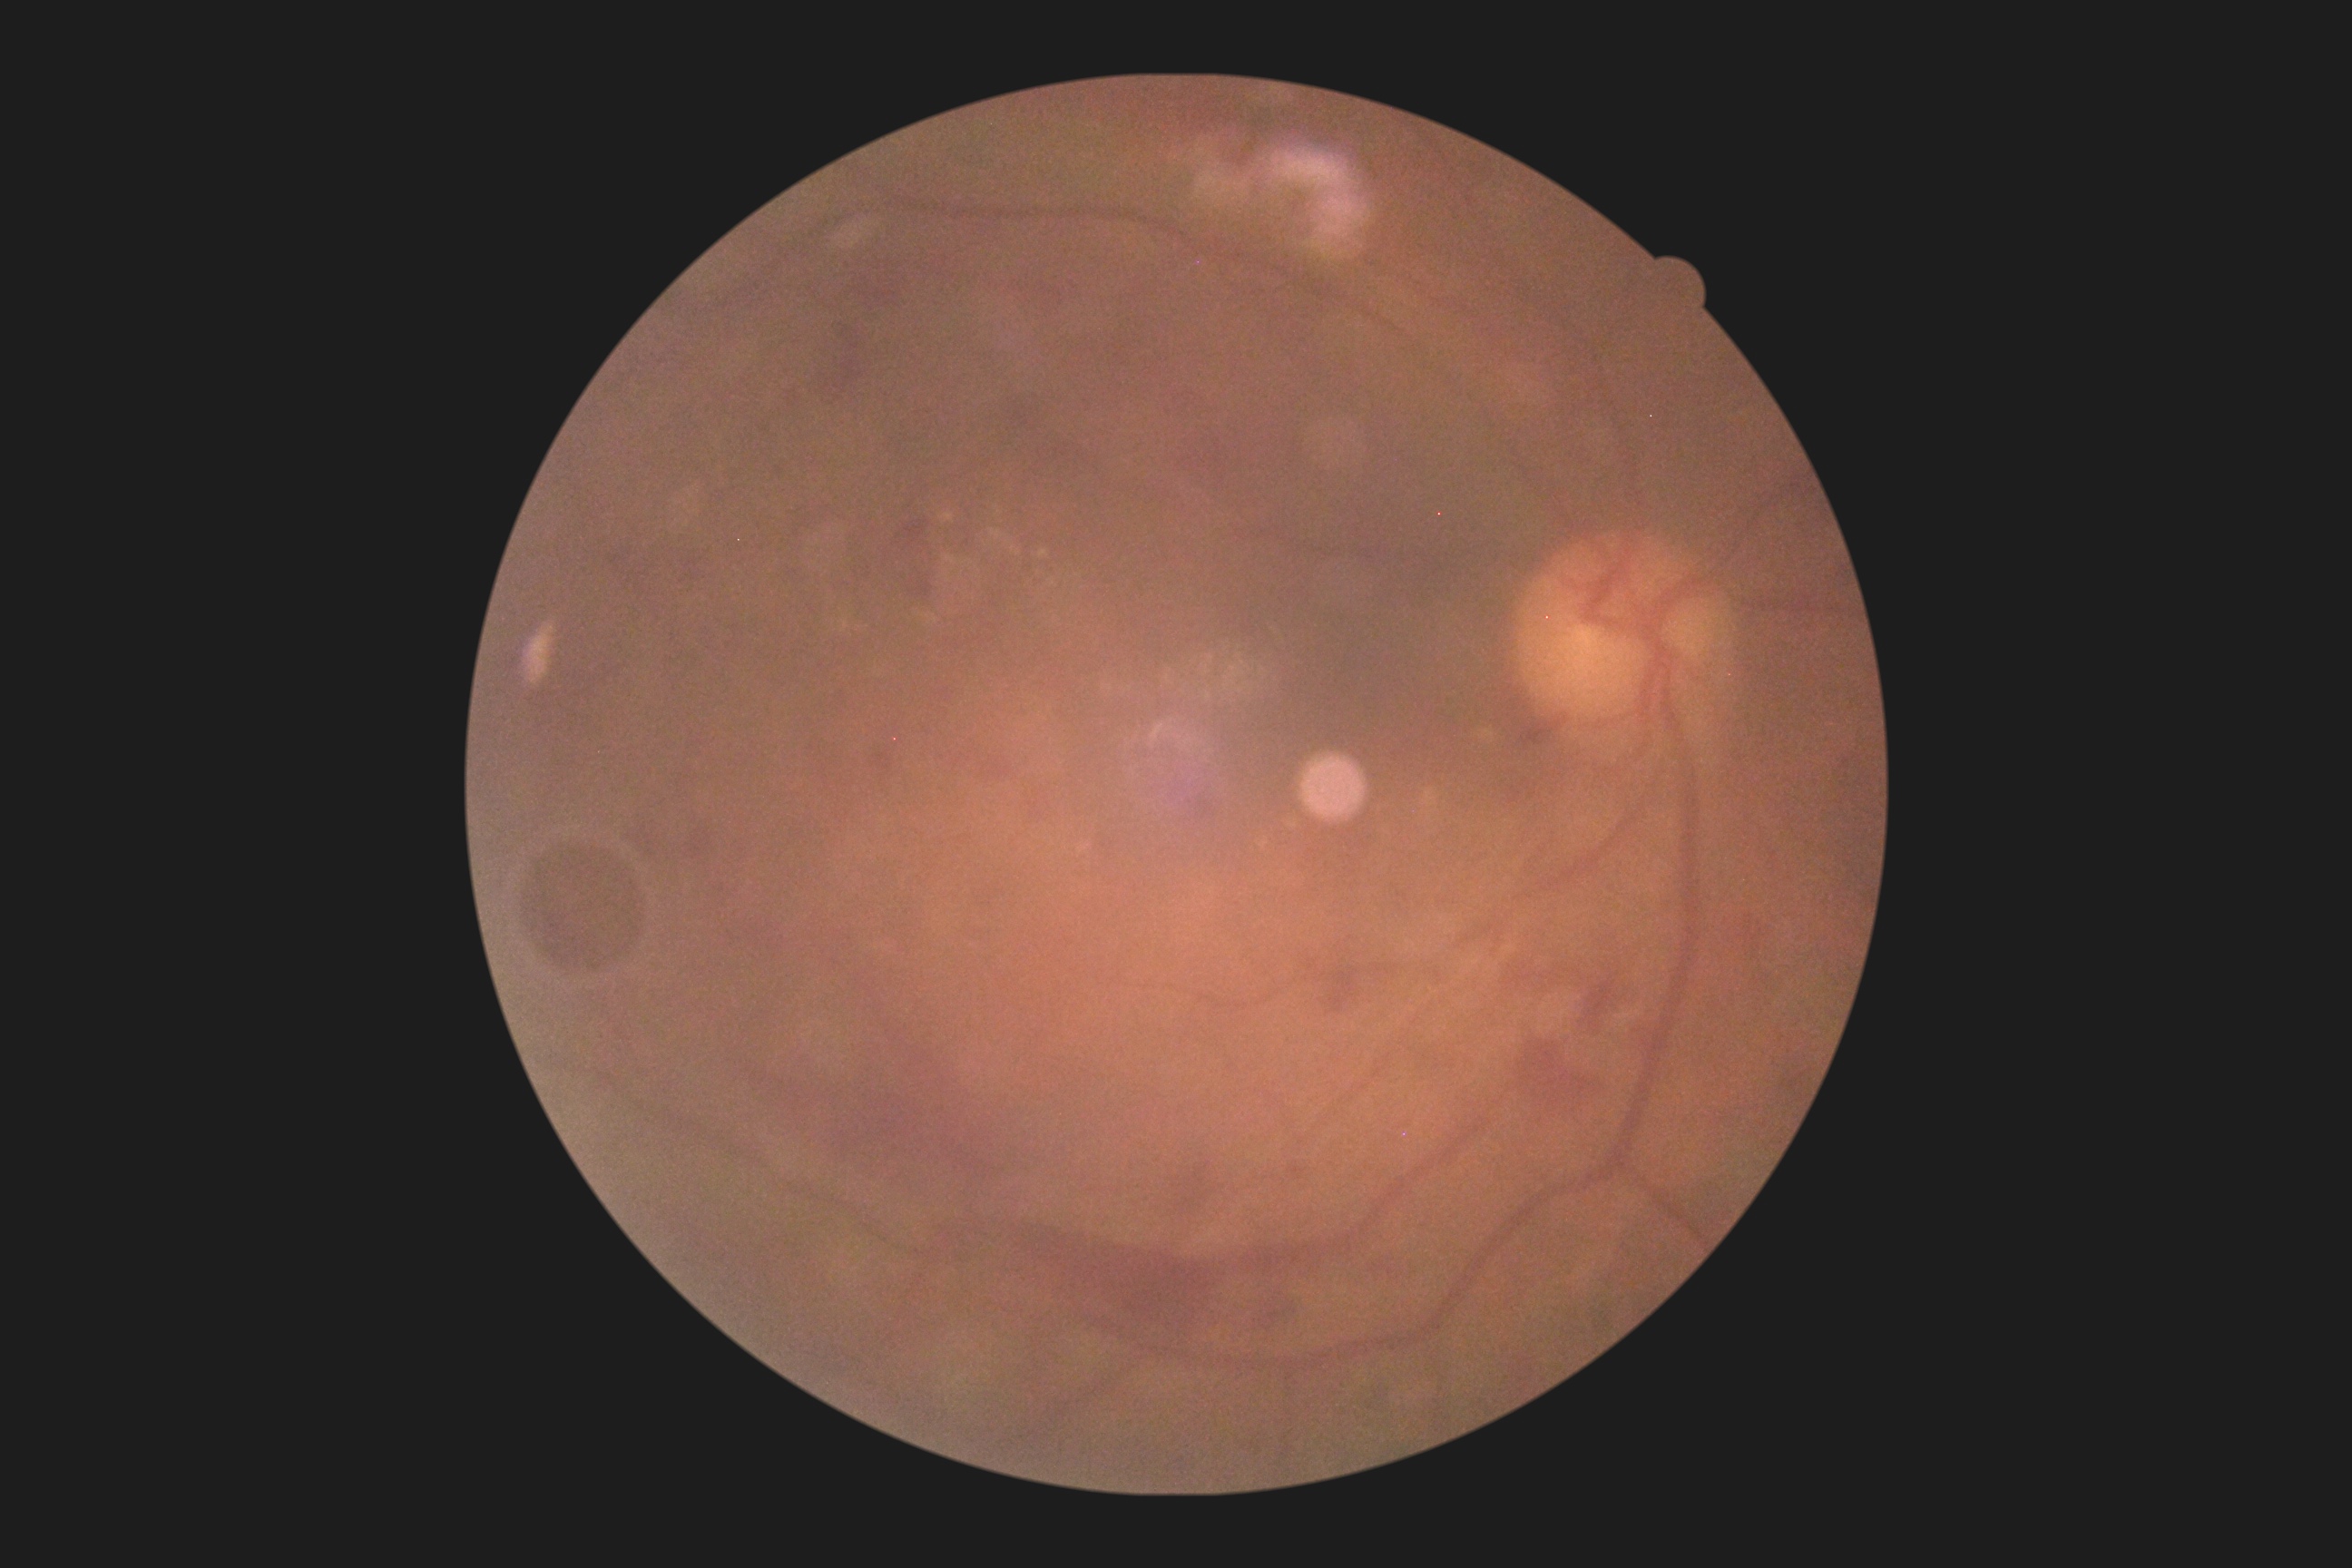 DR class: proliferative diabetic retinopathy; diabetic retinopathy: grade 4 (PDR).